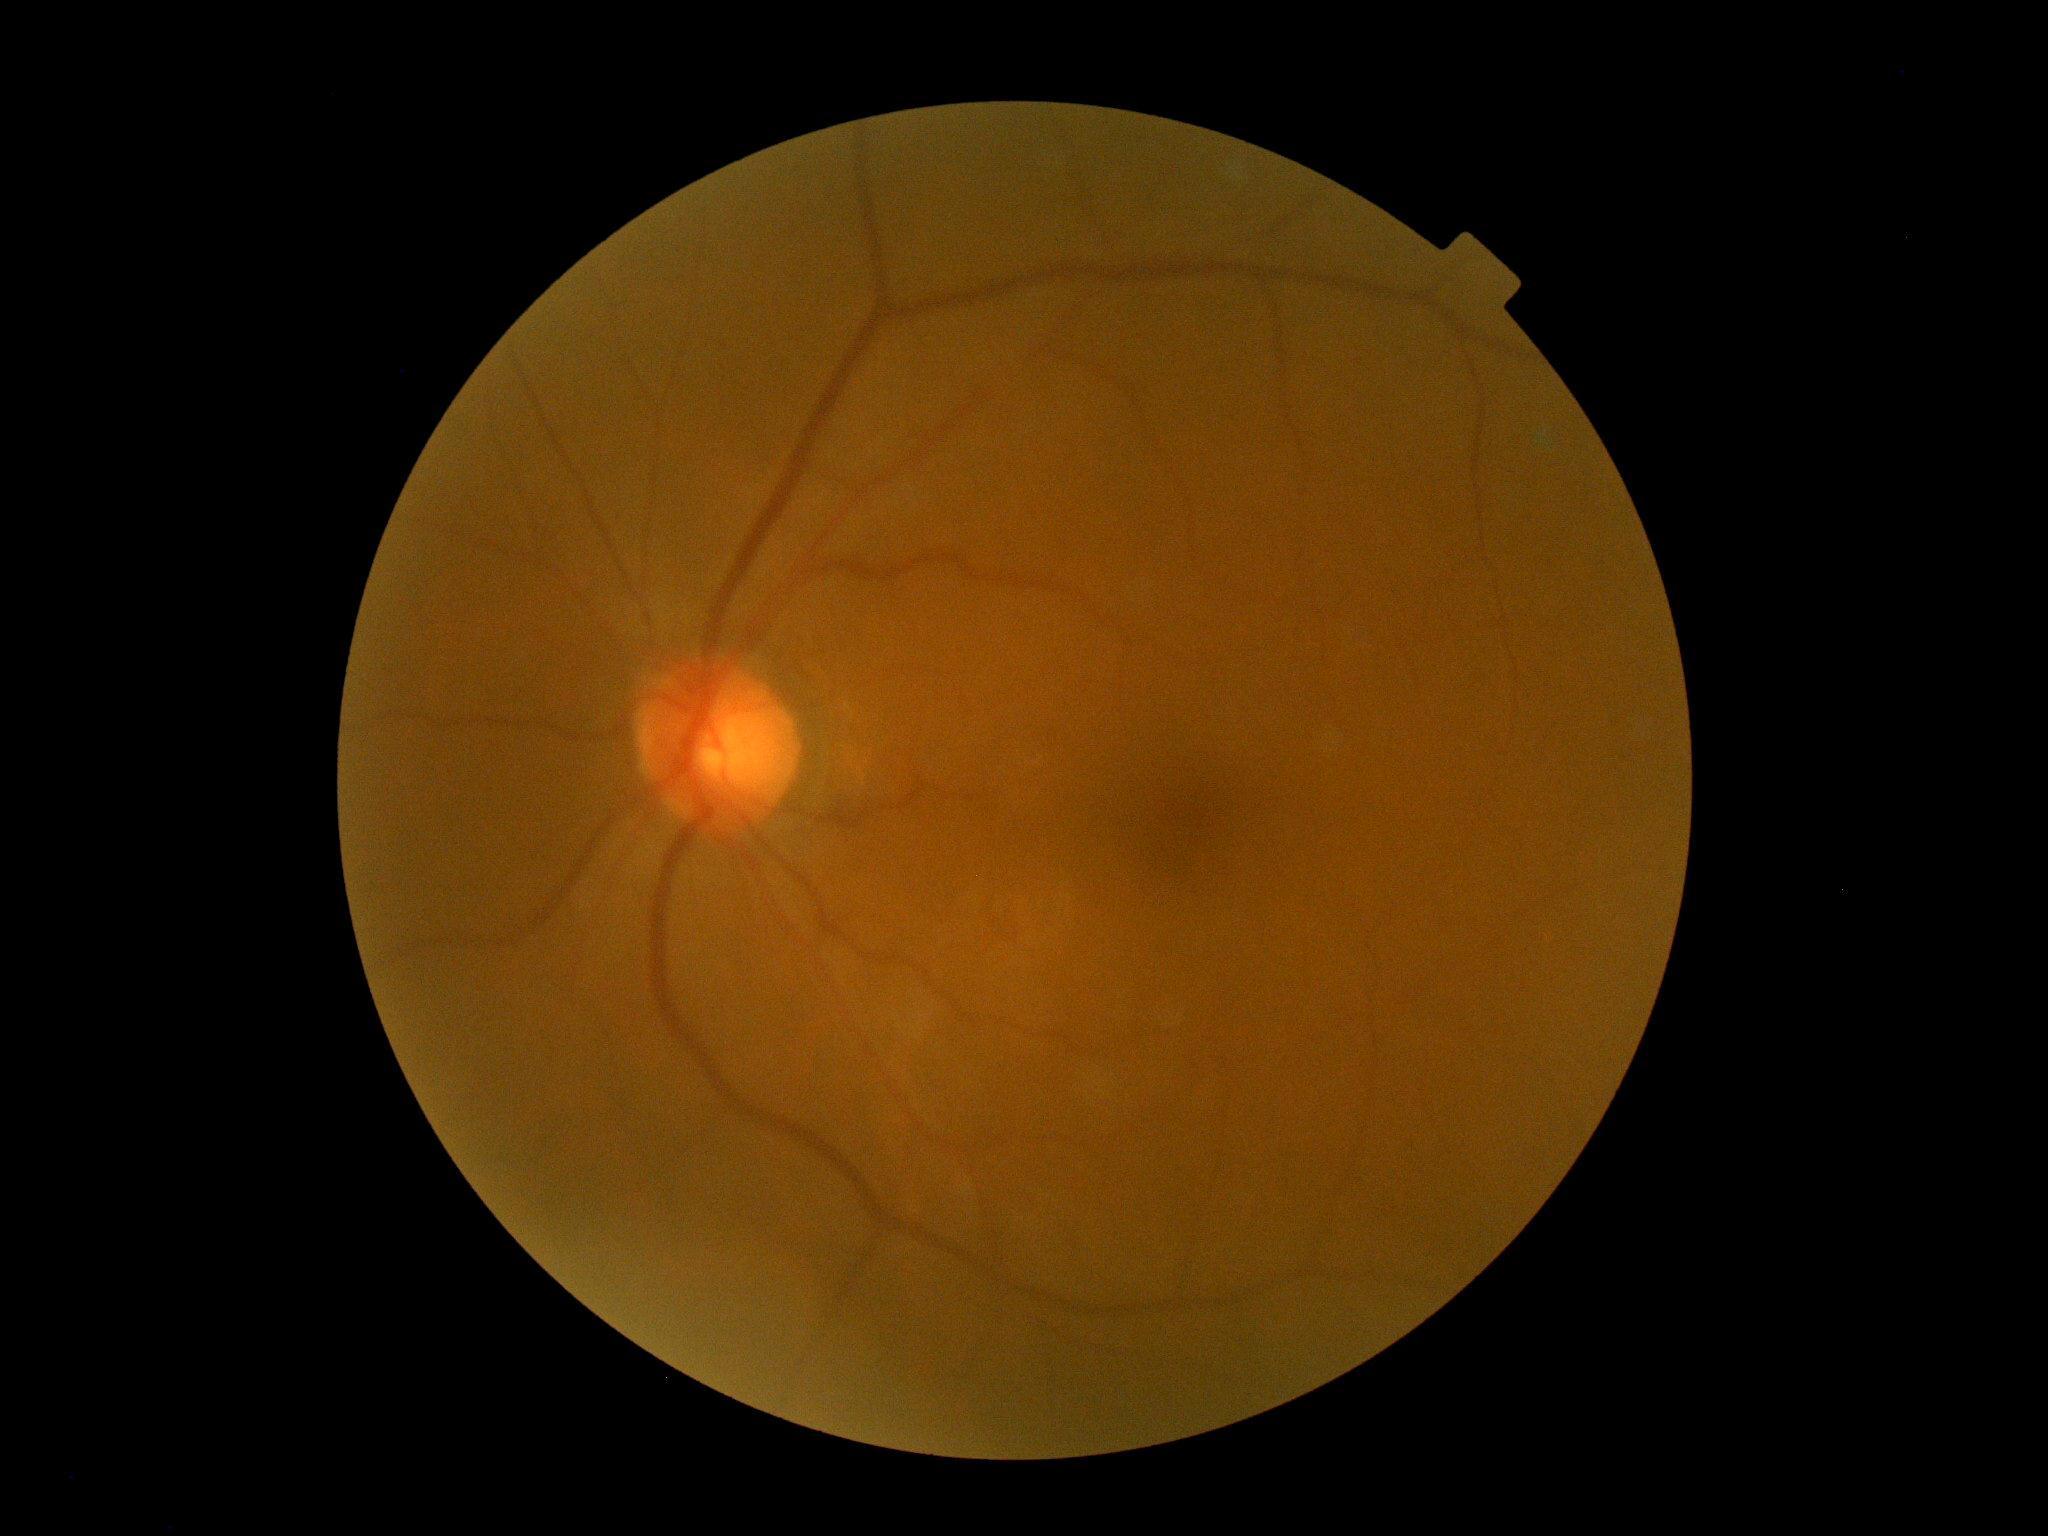 diabetic retinopathy (DR): 0.